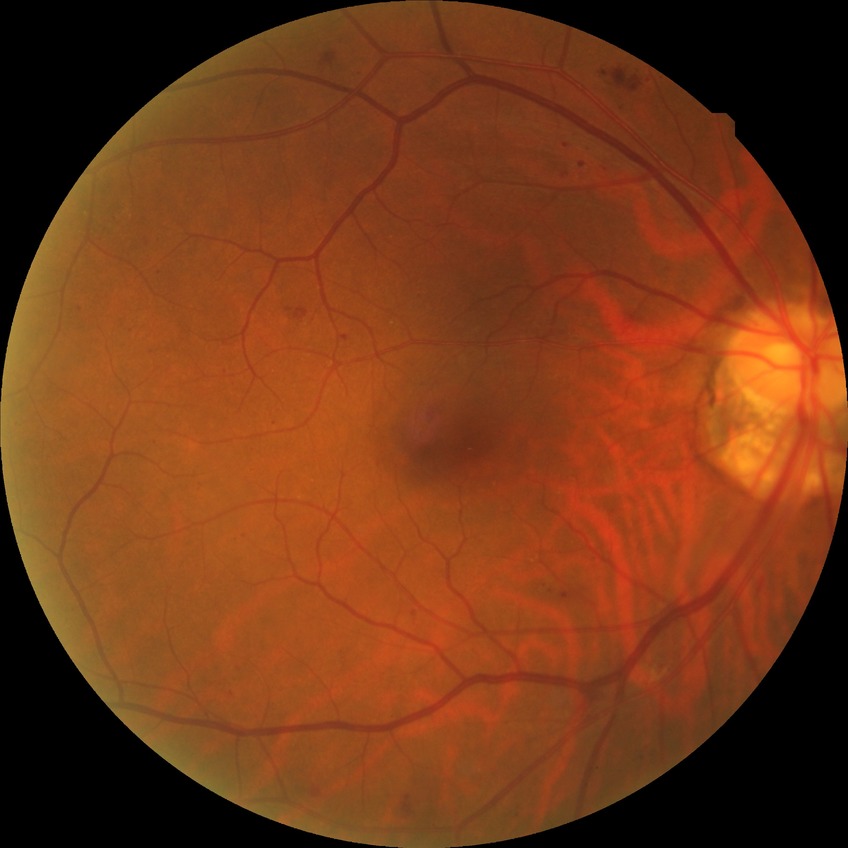

Diabetic retinopathy (DR) is simple diabetic retinopathy (SDR).